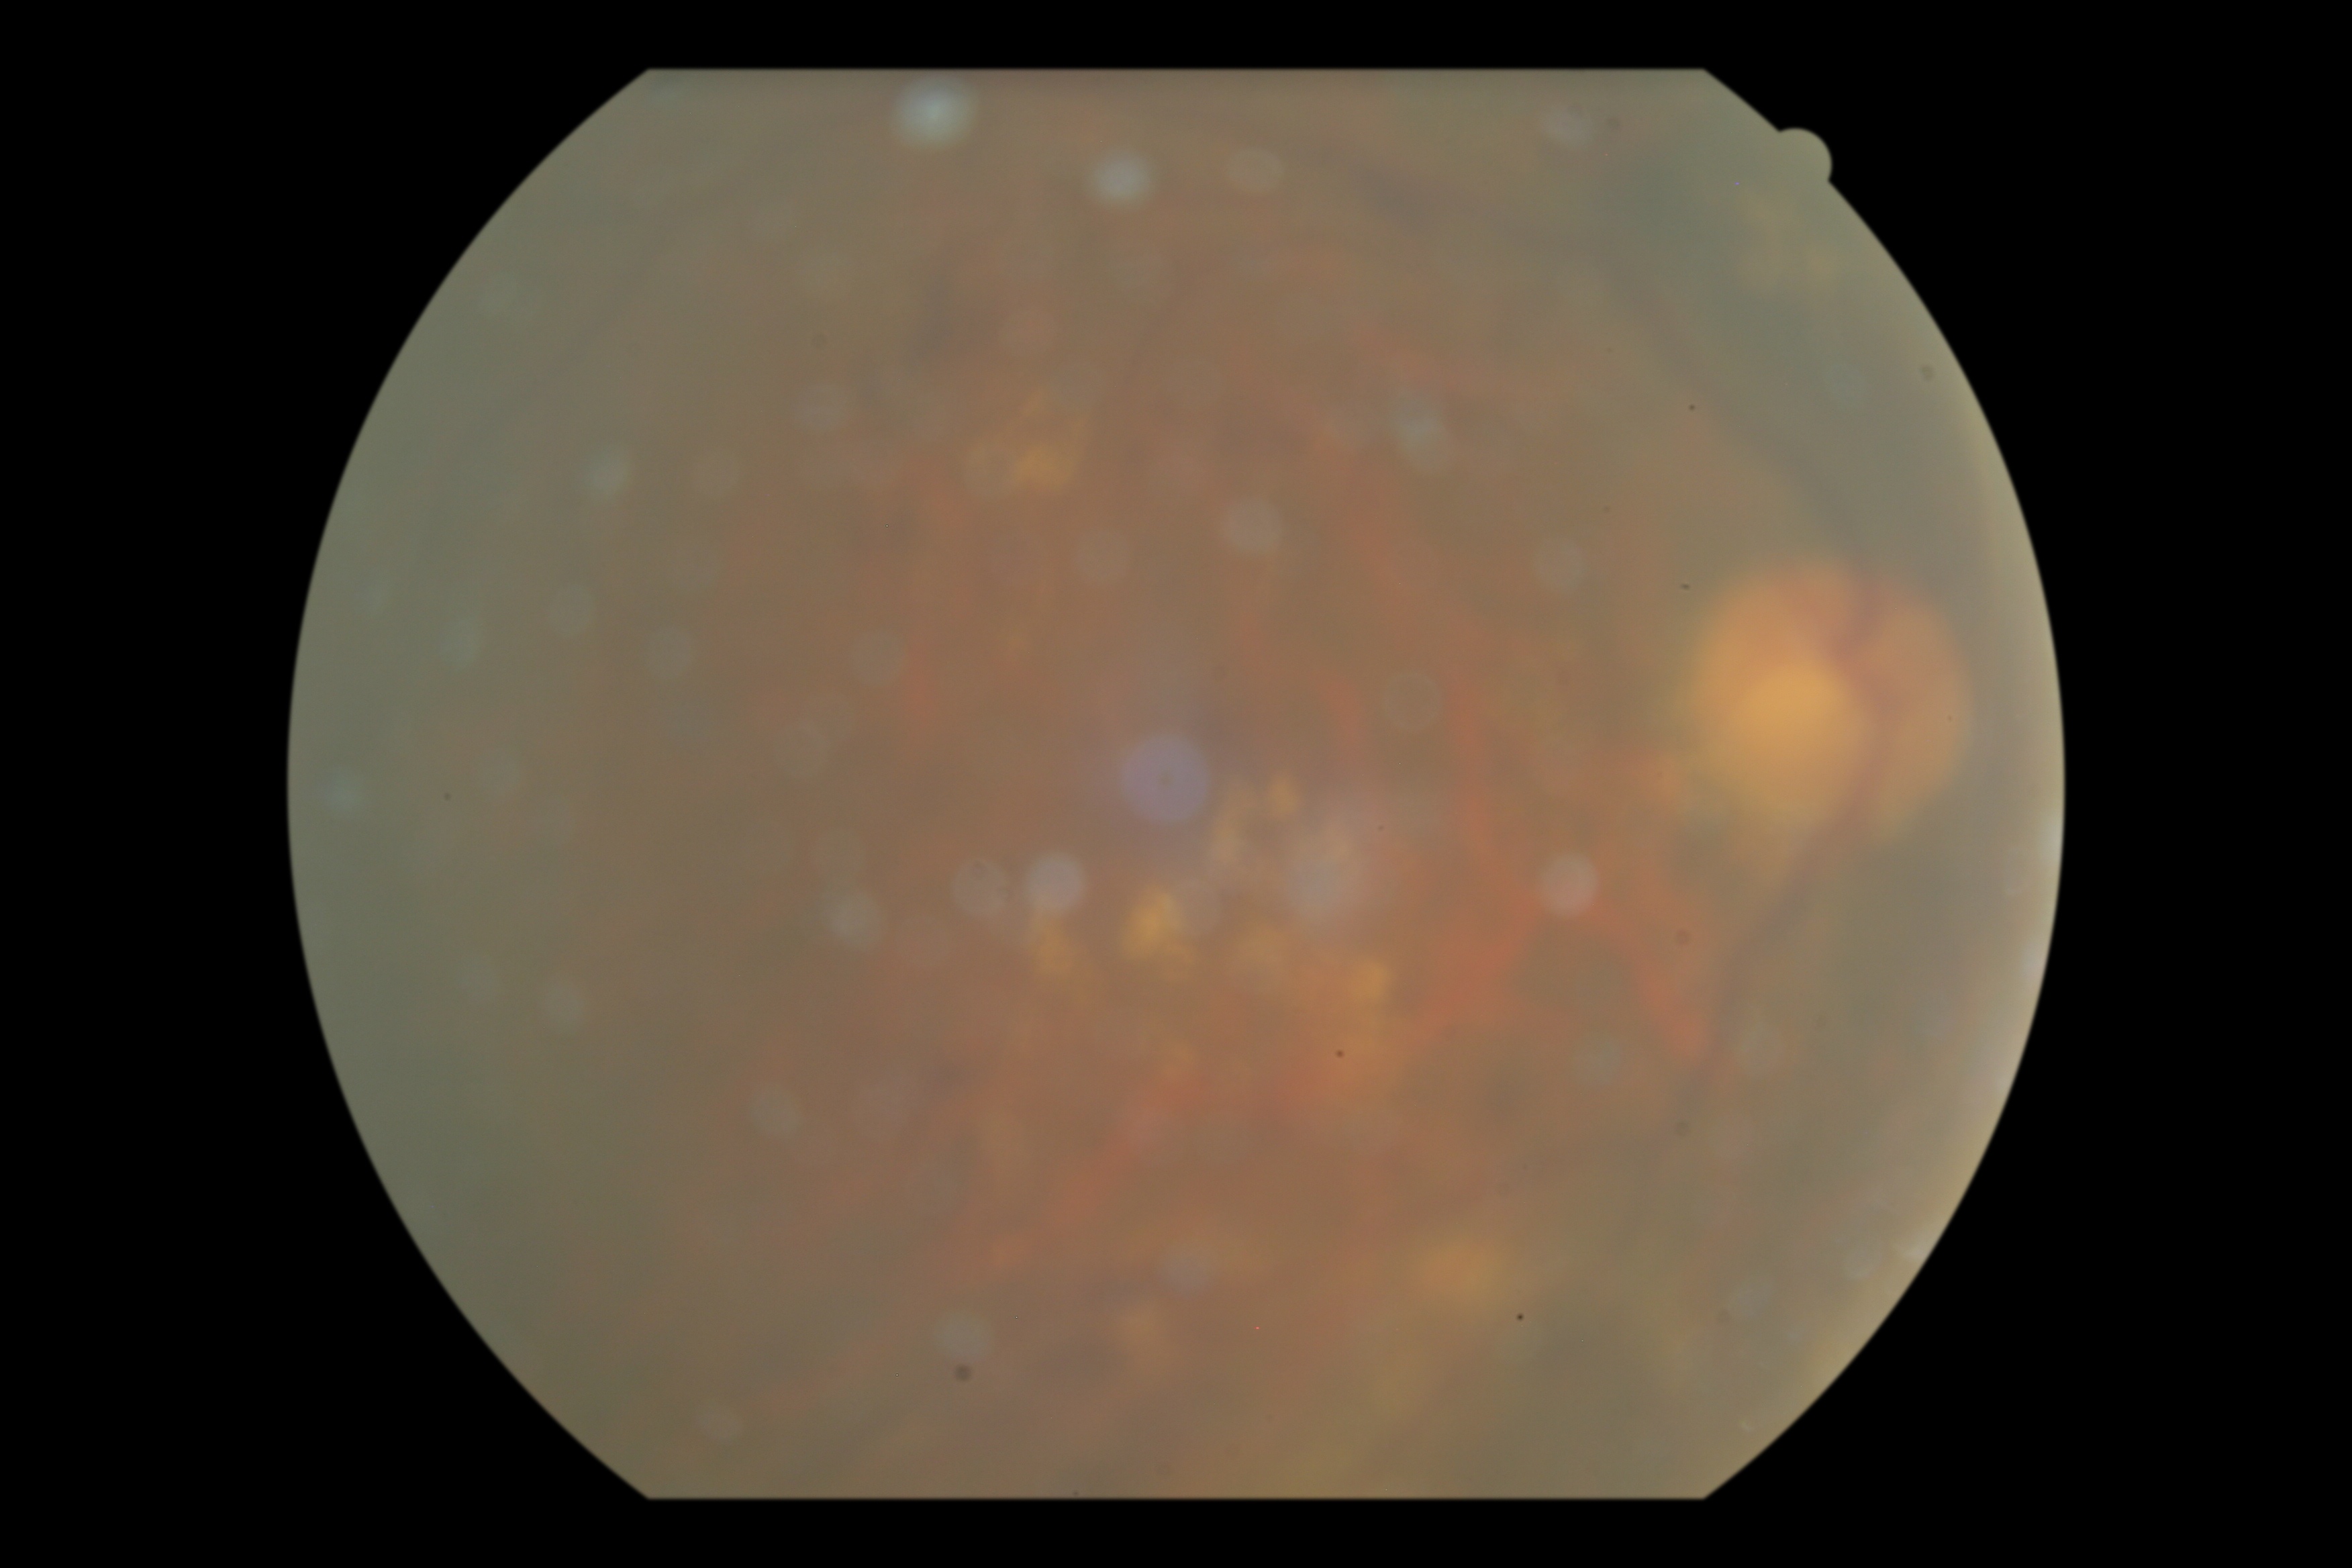
Annotations:
– DR: grade 2